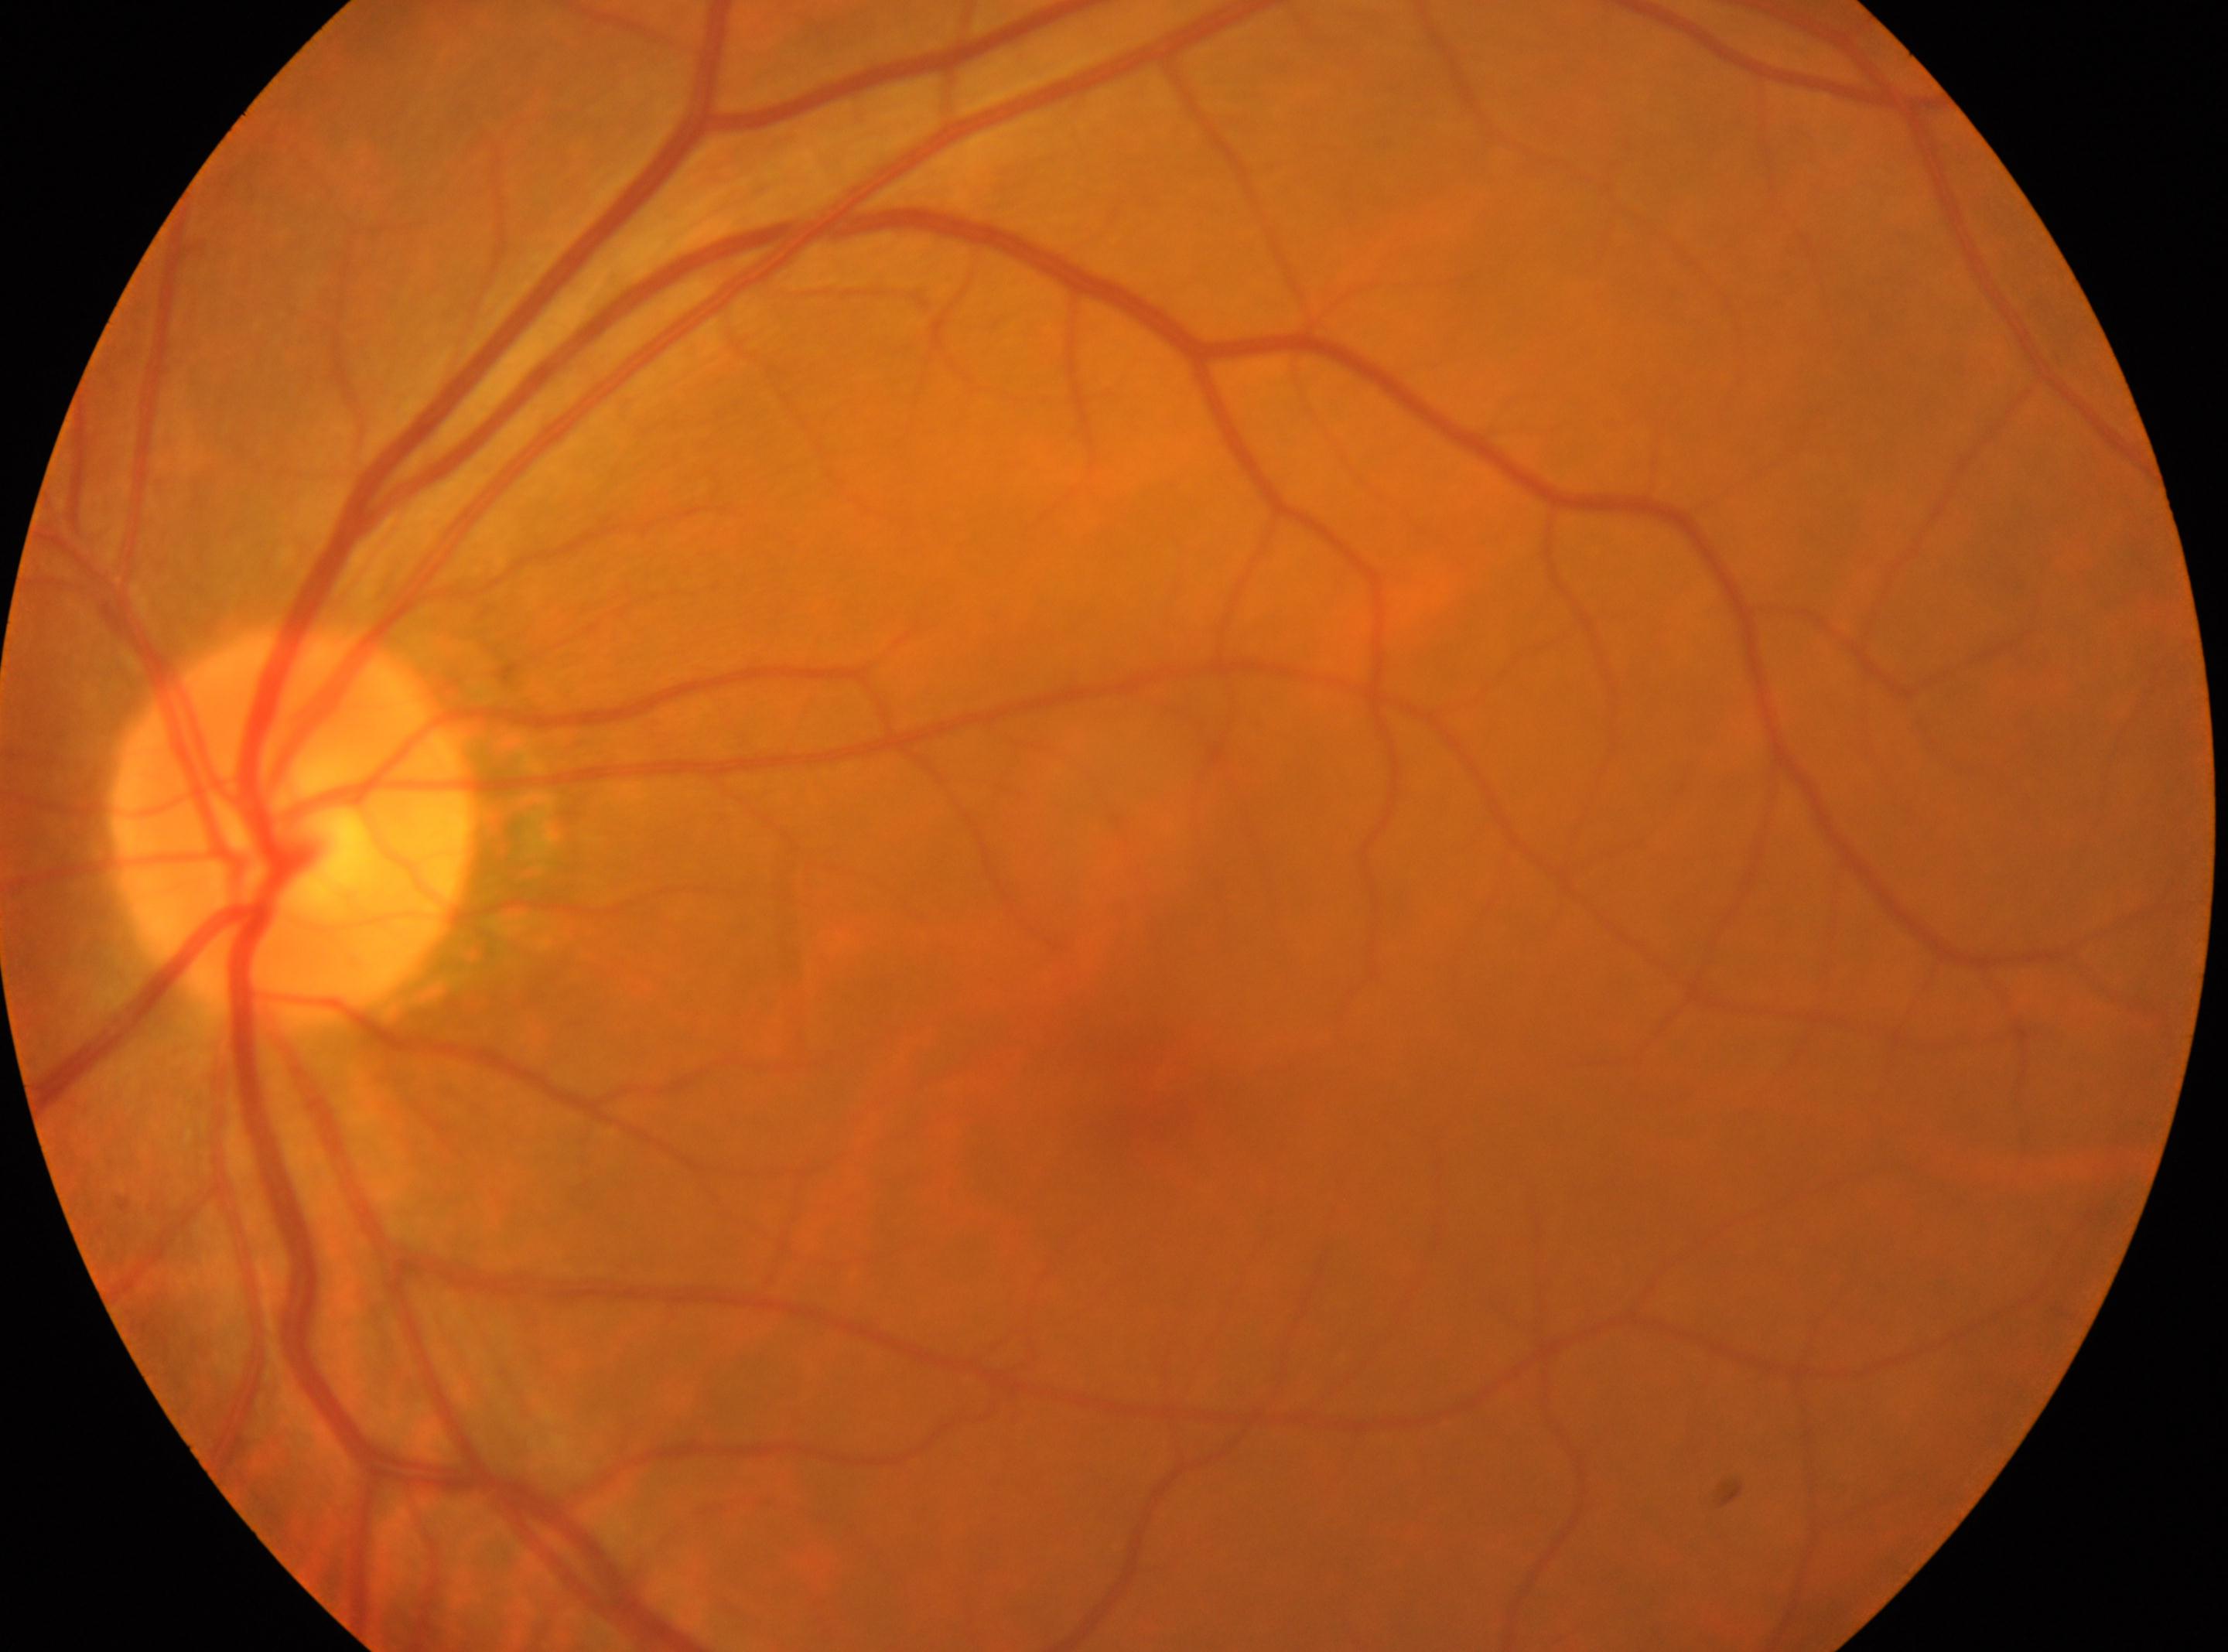 laterality: left, diabetic retinopathy: no apparent retinopathy (grade 0), optic disk: (x: 290, y: 826), foveal center: (x: 1153, y: 1084), DR impression: No diabetic retinopathy identified.